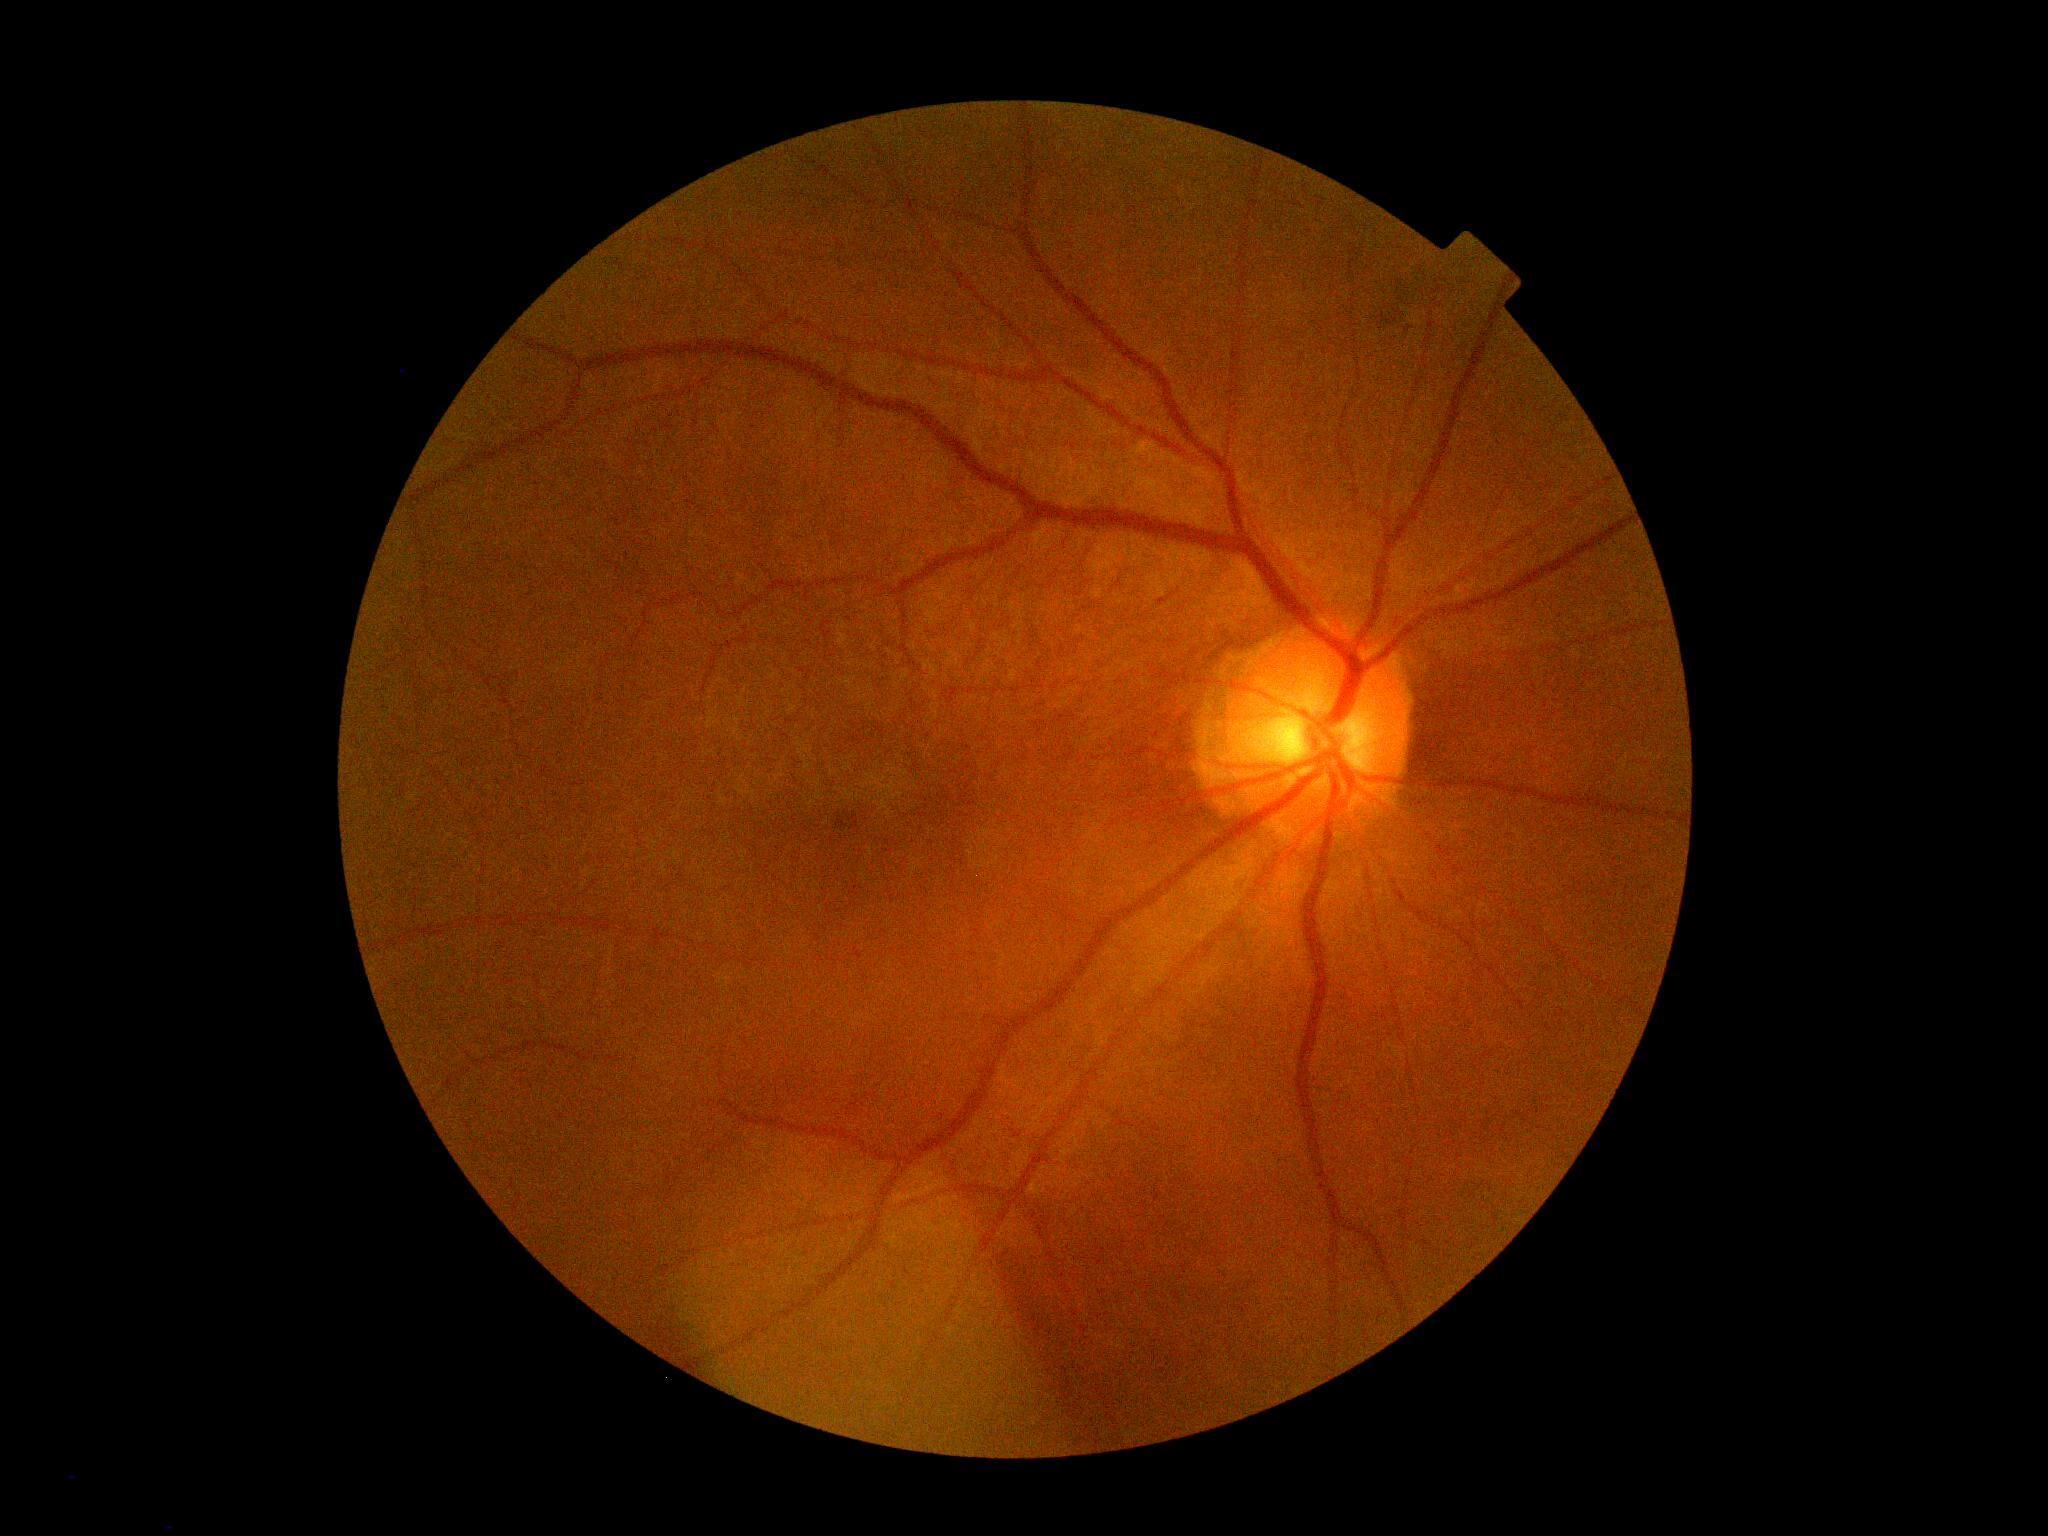
dr_grade: moderate non-proliferative diabetic retinopathy (grade 2) — more than just microaneurysms but less than severe NPDR